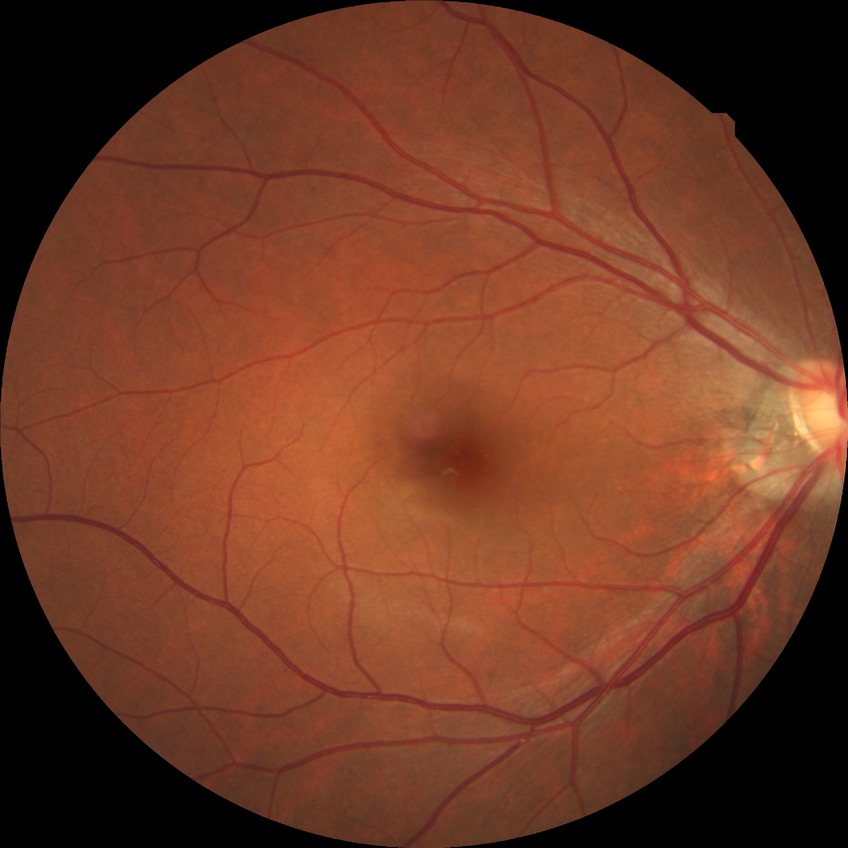
Diabetic retinopathy (DR) is NDR (no diabetic retinopathy).